Kowa VX-10α; macula-centered; color fundus photograph
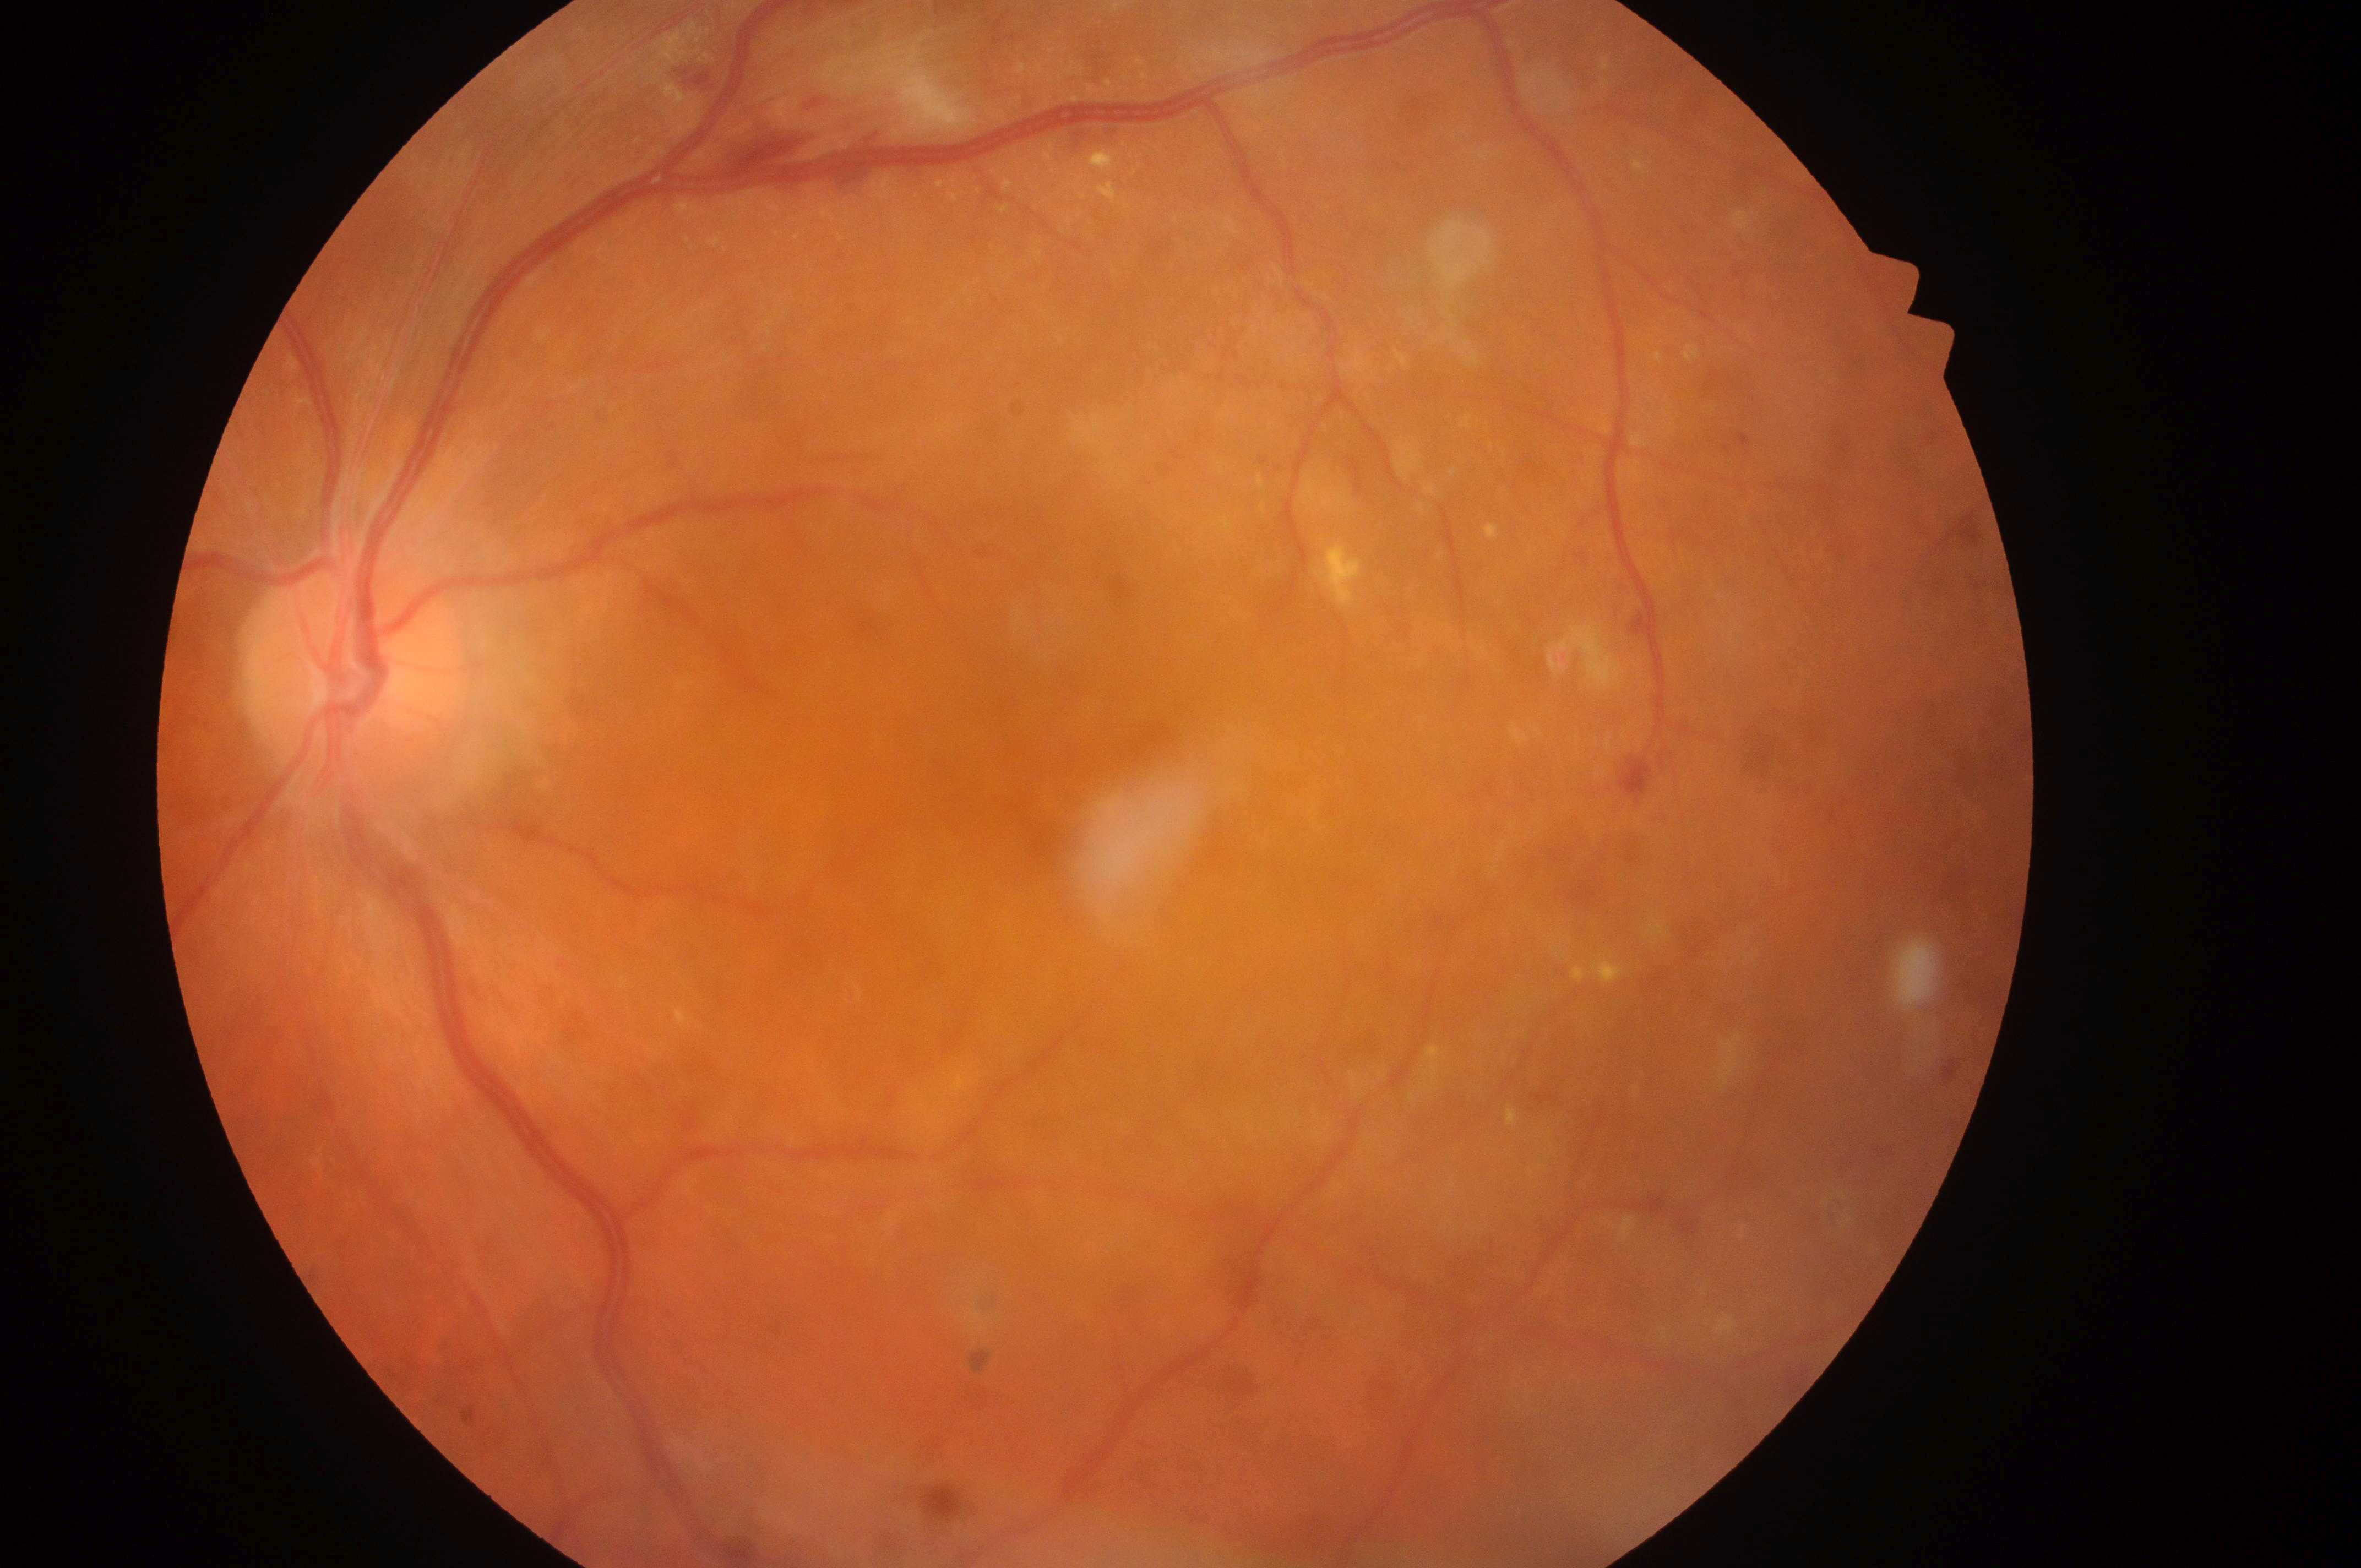

* laterality — the left eye
* optic disc — (352, 676)
* foveal center — (1109, 804)
* diabetic retinopathy grade — moderate NPDR (2)
* macular edema — grade 1 (low risk)